Pediatric retinal photograph (wide-field) · captured with the Clarity RetCam 3 (130° field of view):
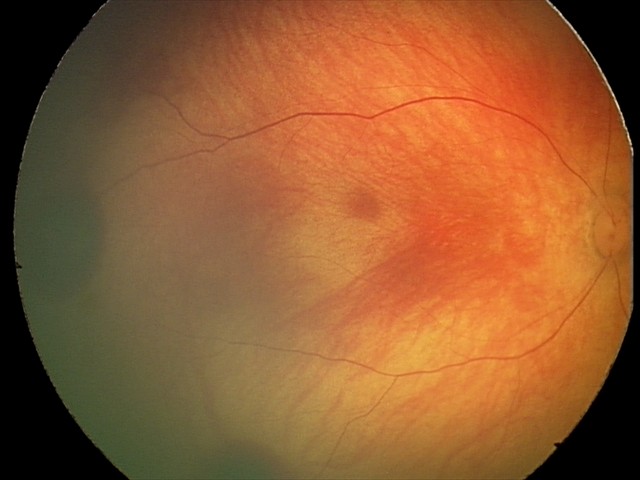

Series diagnosed as retinal hemorrhages.